Wide-field fundus photograph of an infant · 1240x1240: 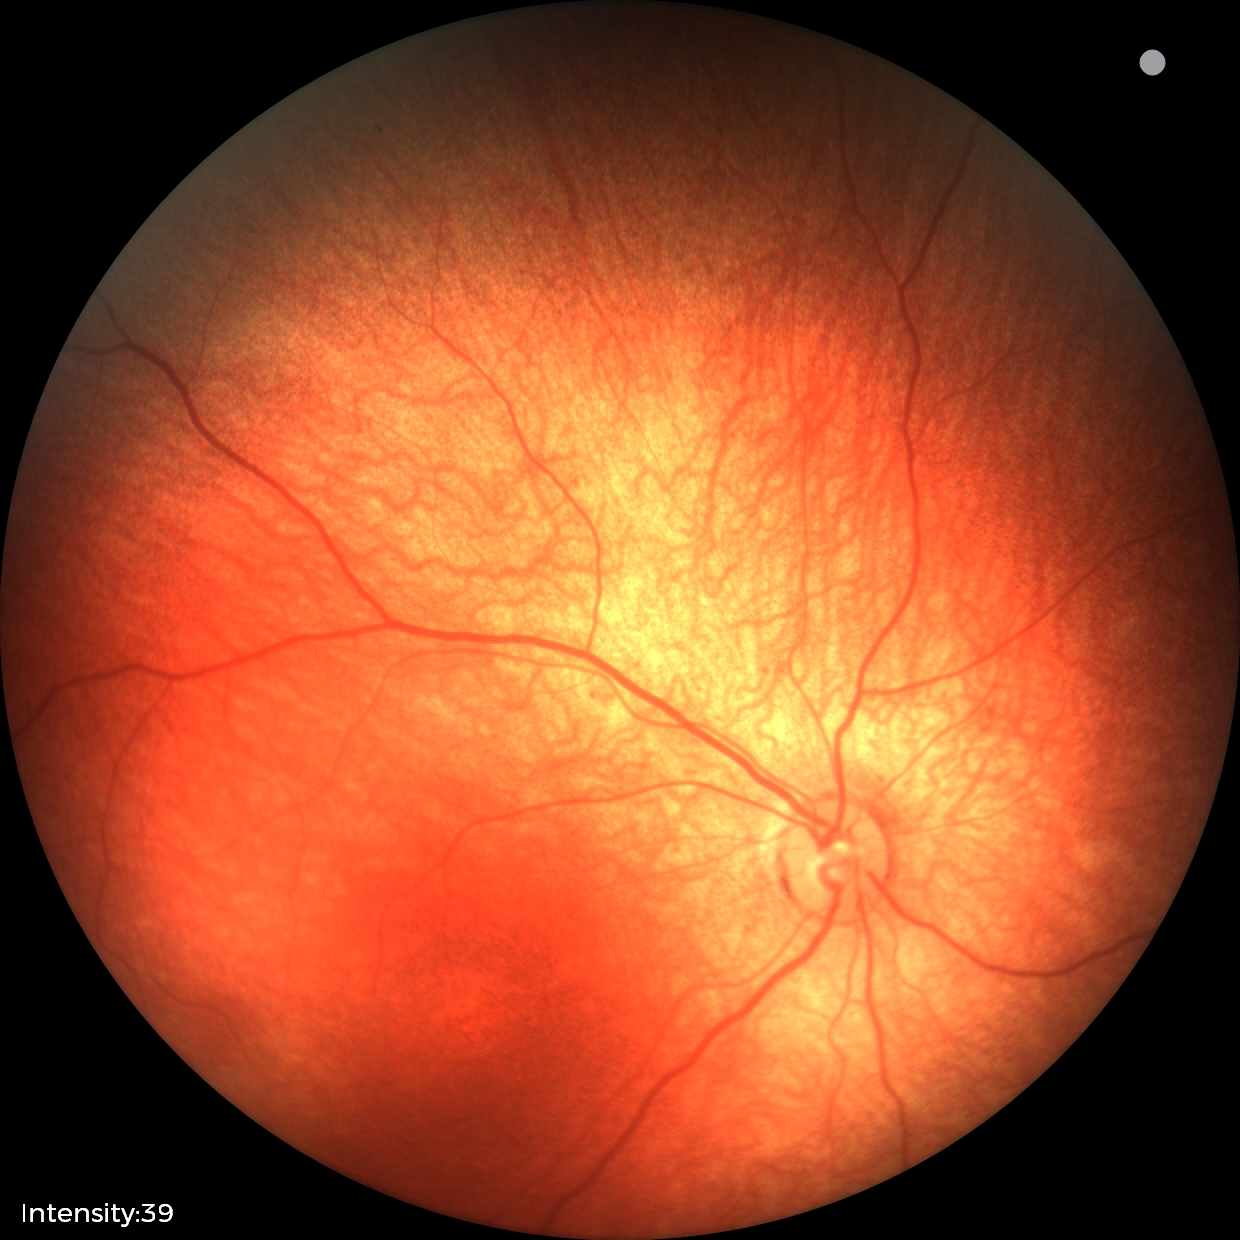

Screening diagnosis: normal retinal appearance.